1380x1382px
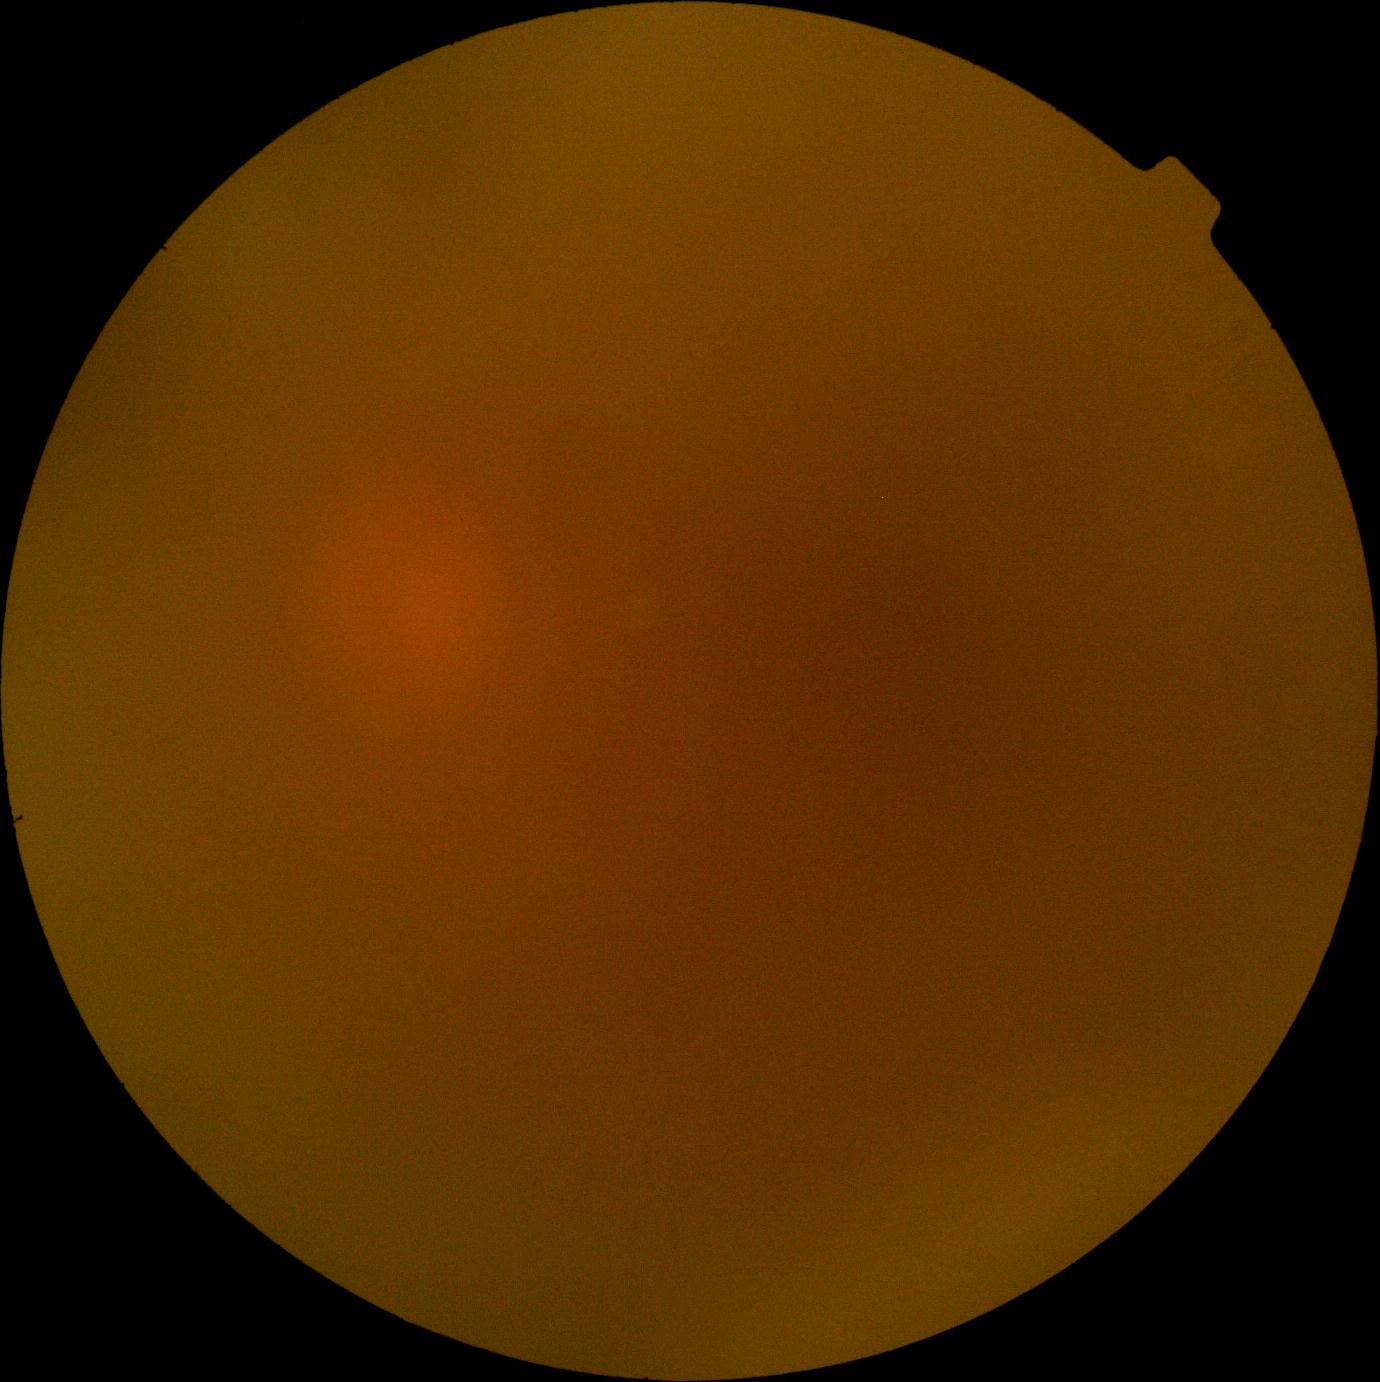

Retinopathy: ungradable.
The image cannot be graded for diabetic retinopathy.